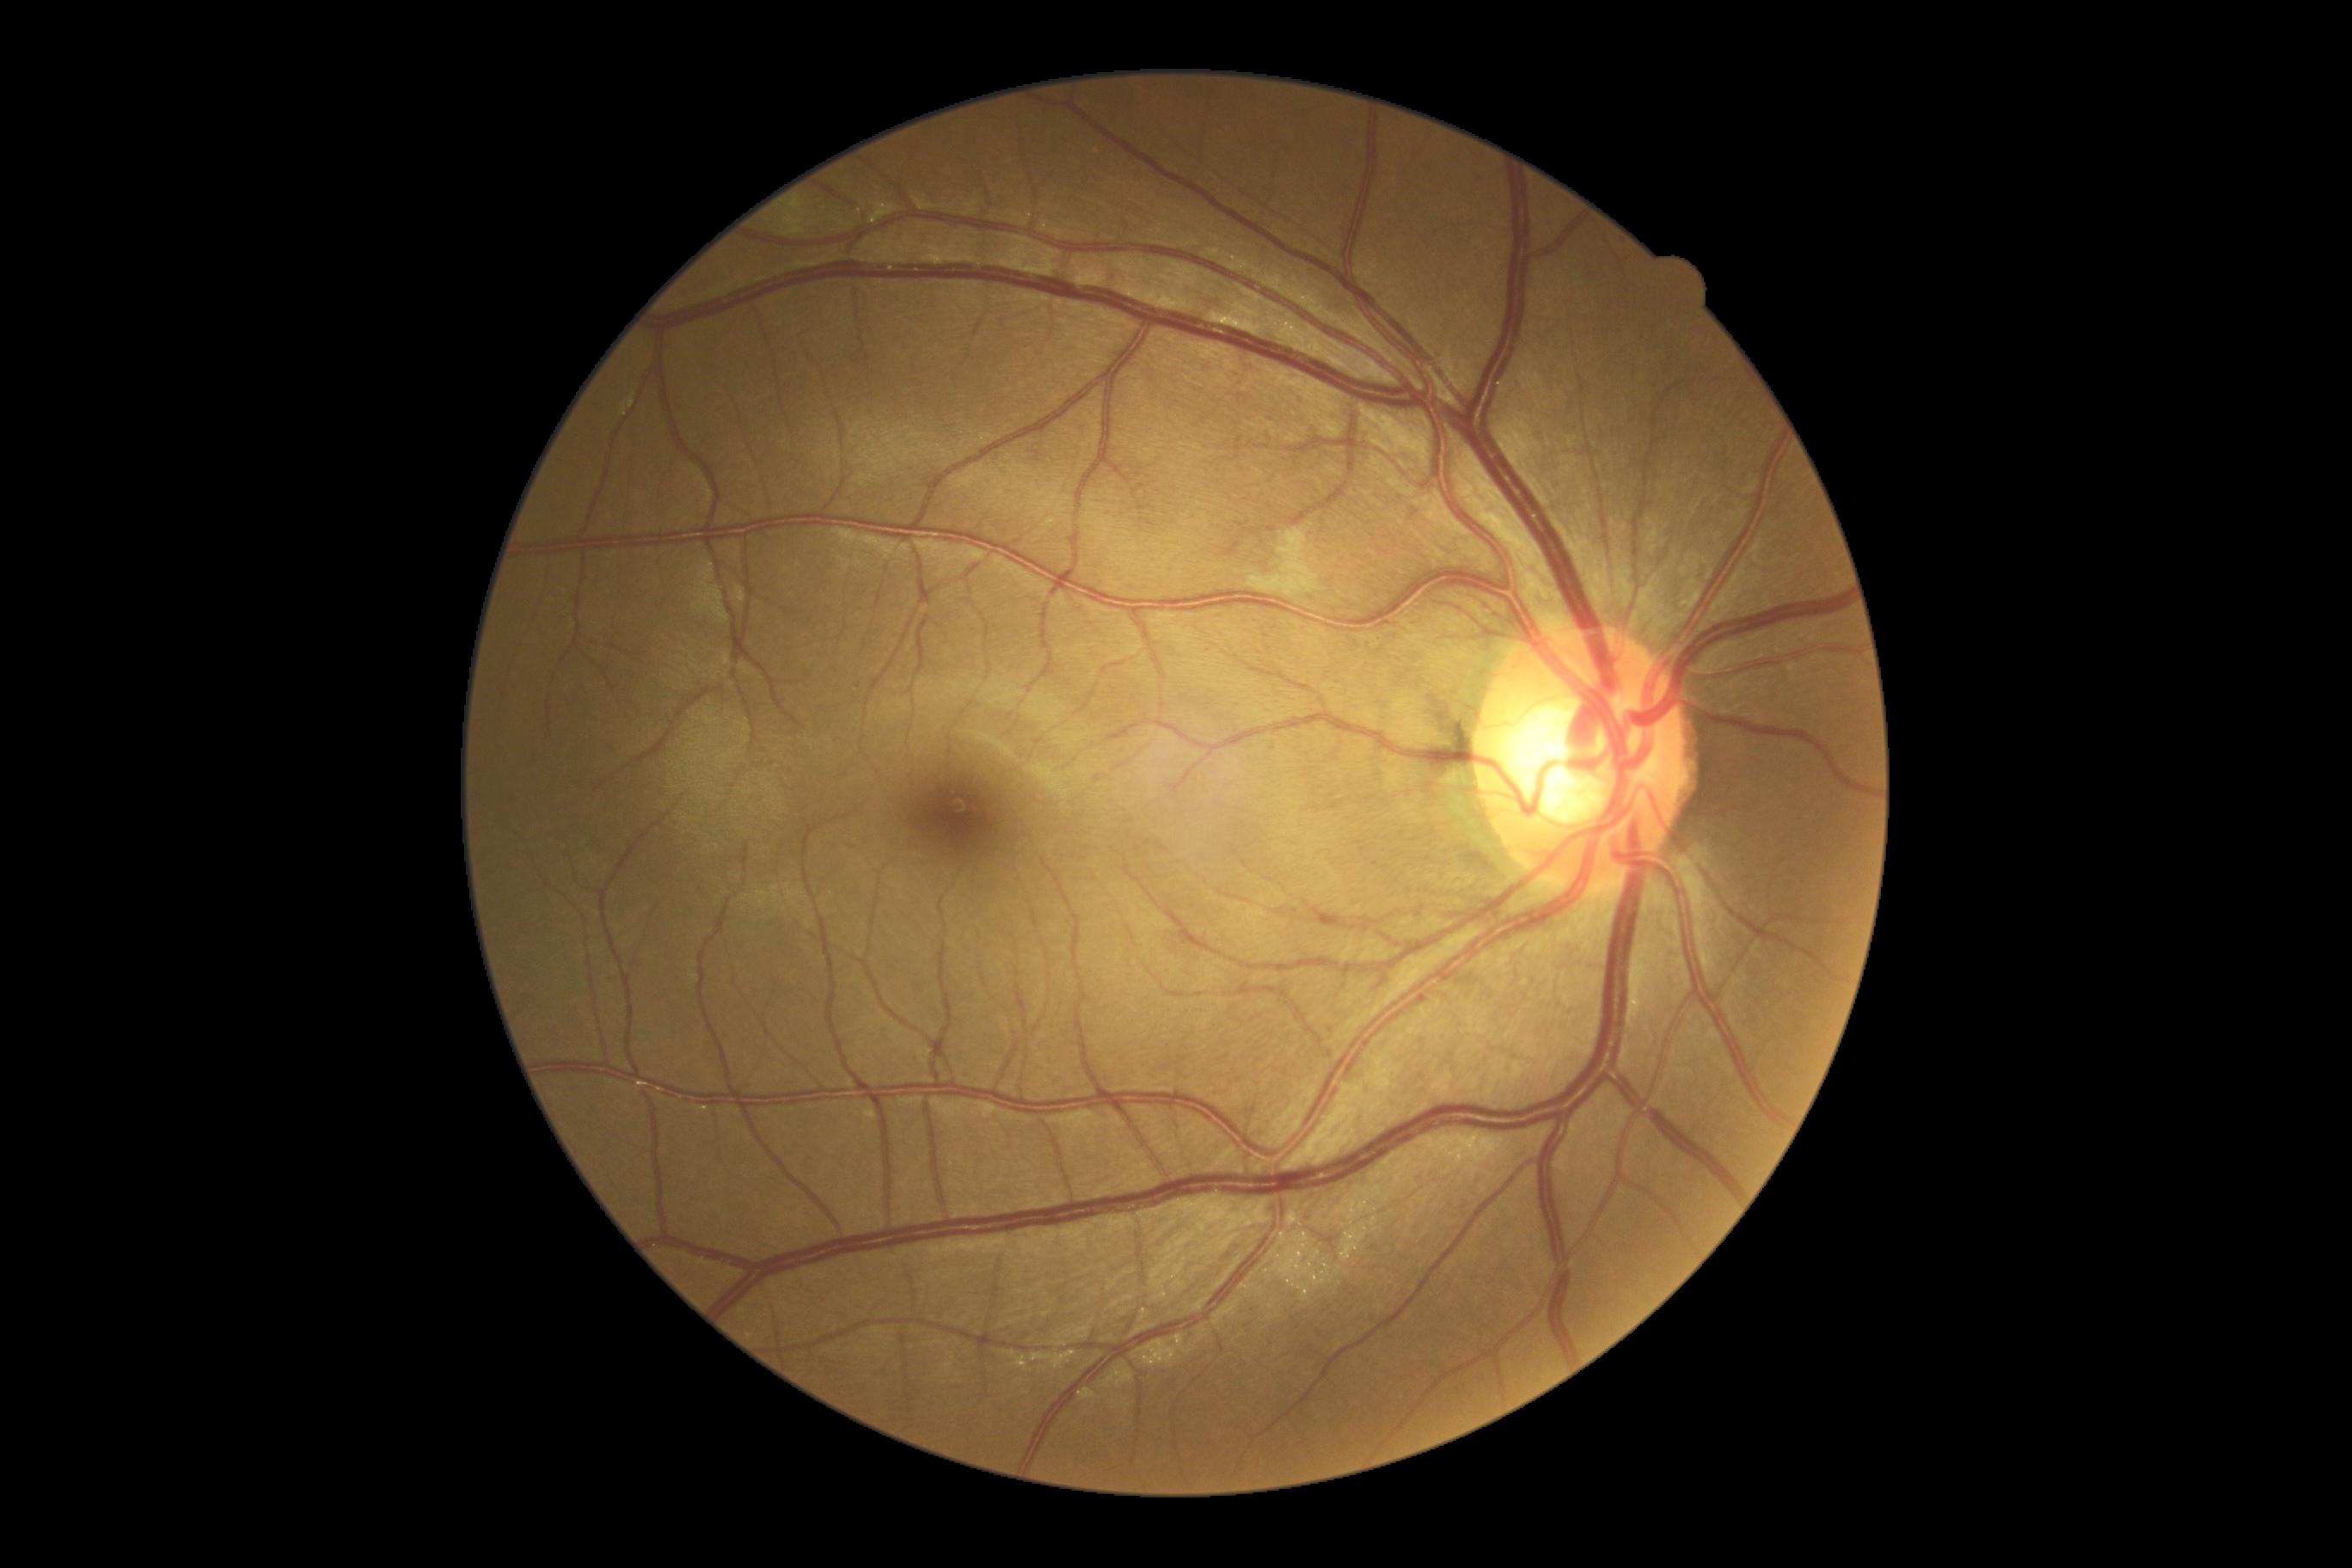
Retinopathy is grade 2 (moderate NPDR).